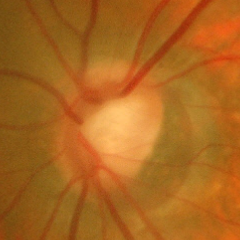
Glaucomatous optic neuropathy is present.
Early glaucomatous changes.
Diagnostic criteria: glaucomatous retinal nerve fiber layer defects on red-free fundus photography without visual field defects.